50° field of view; color fundus image; centered on the macula:
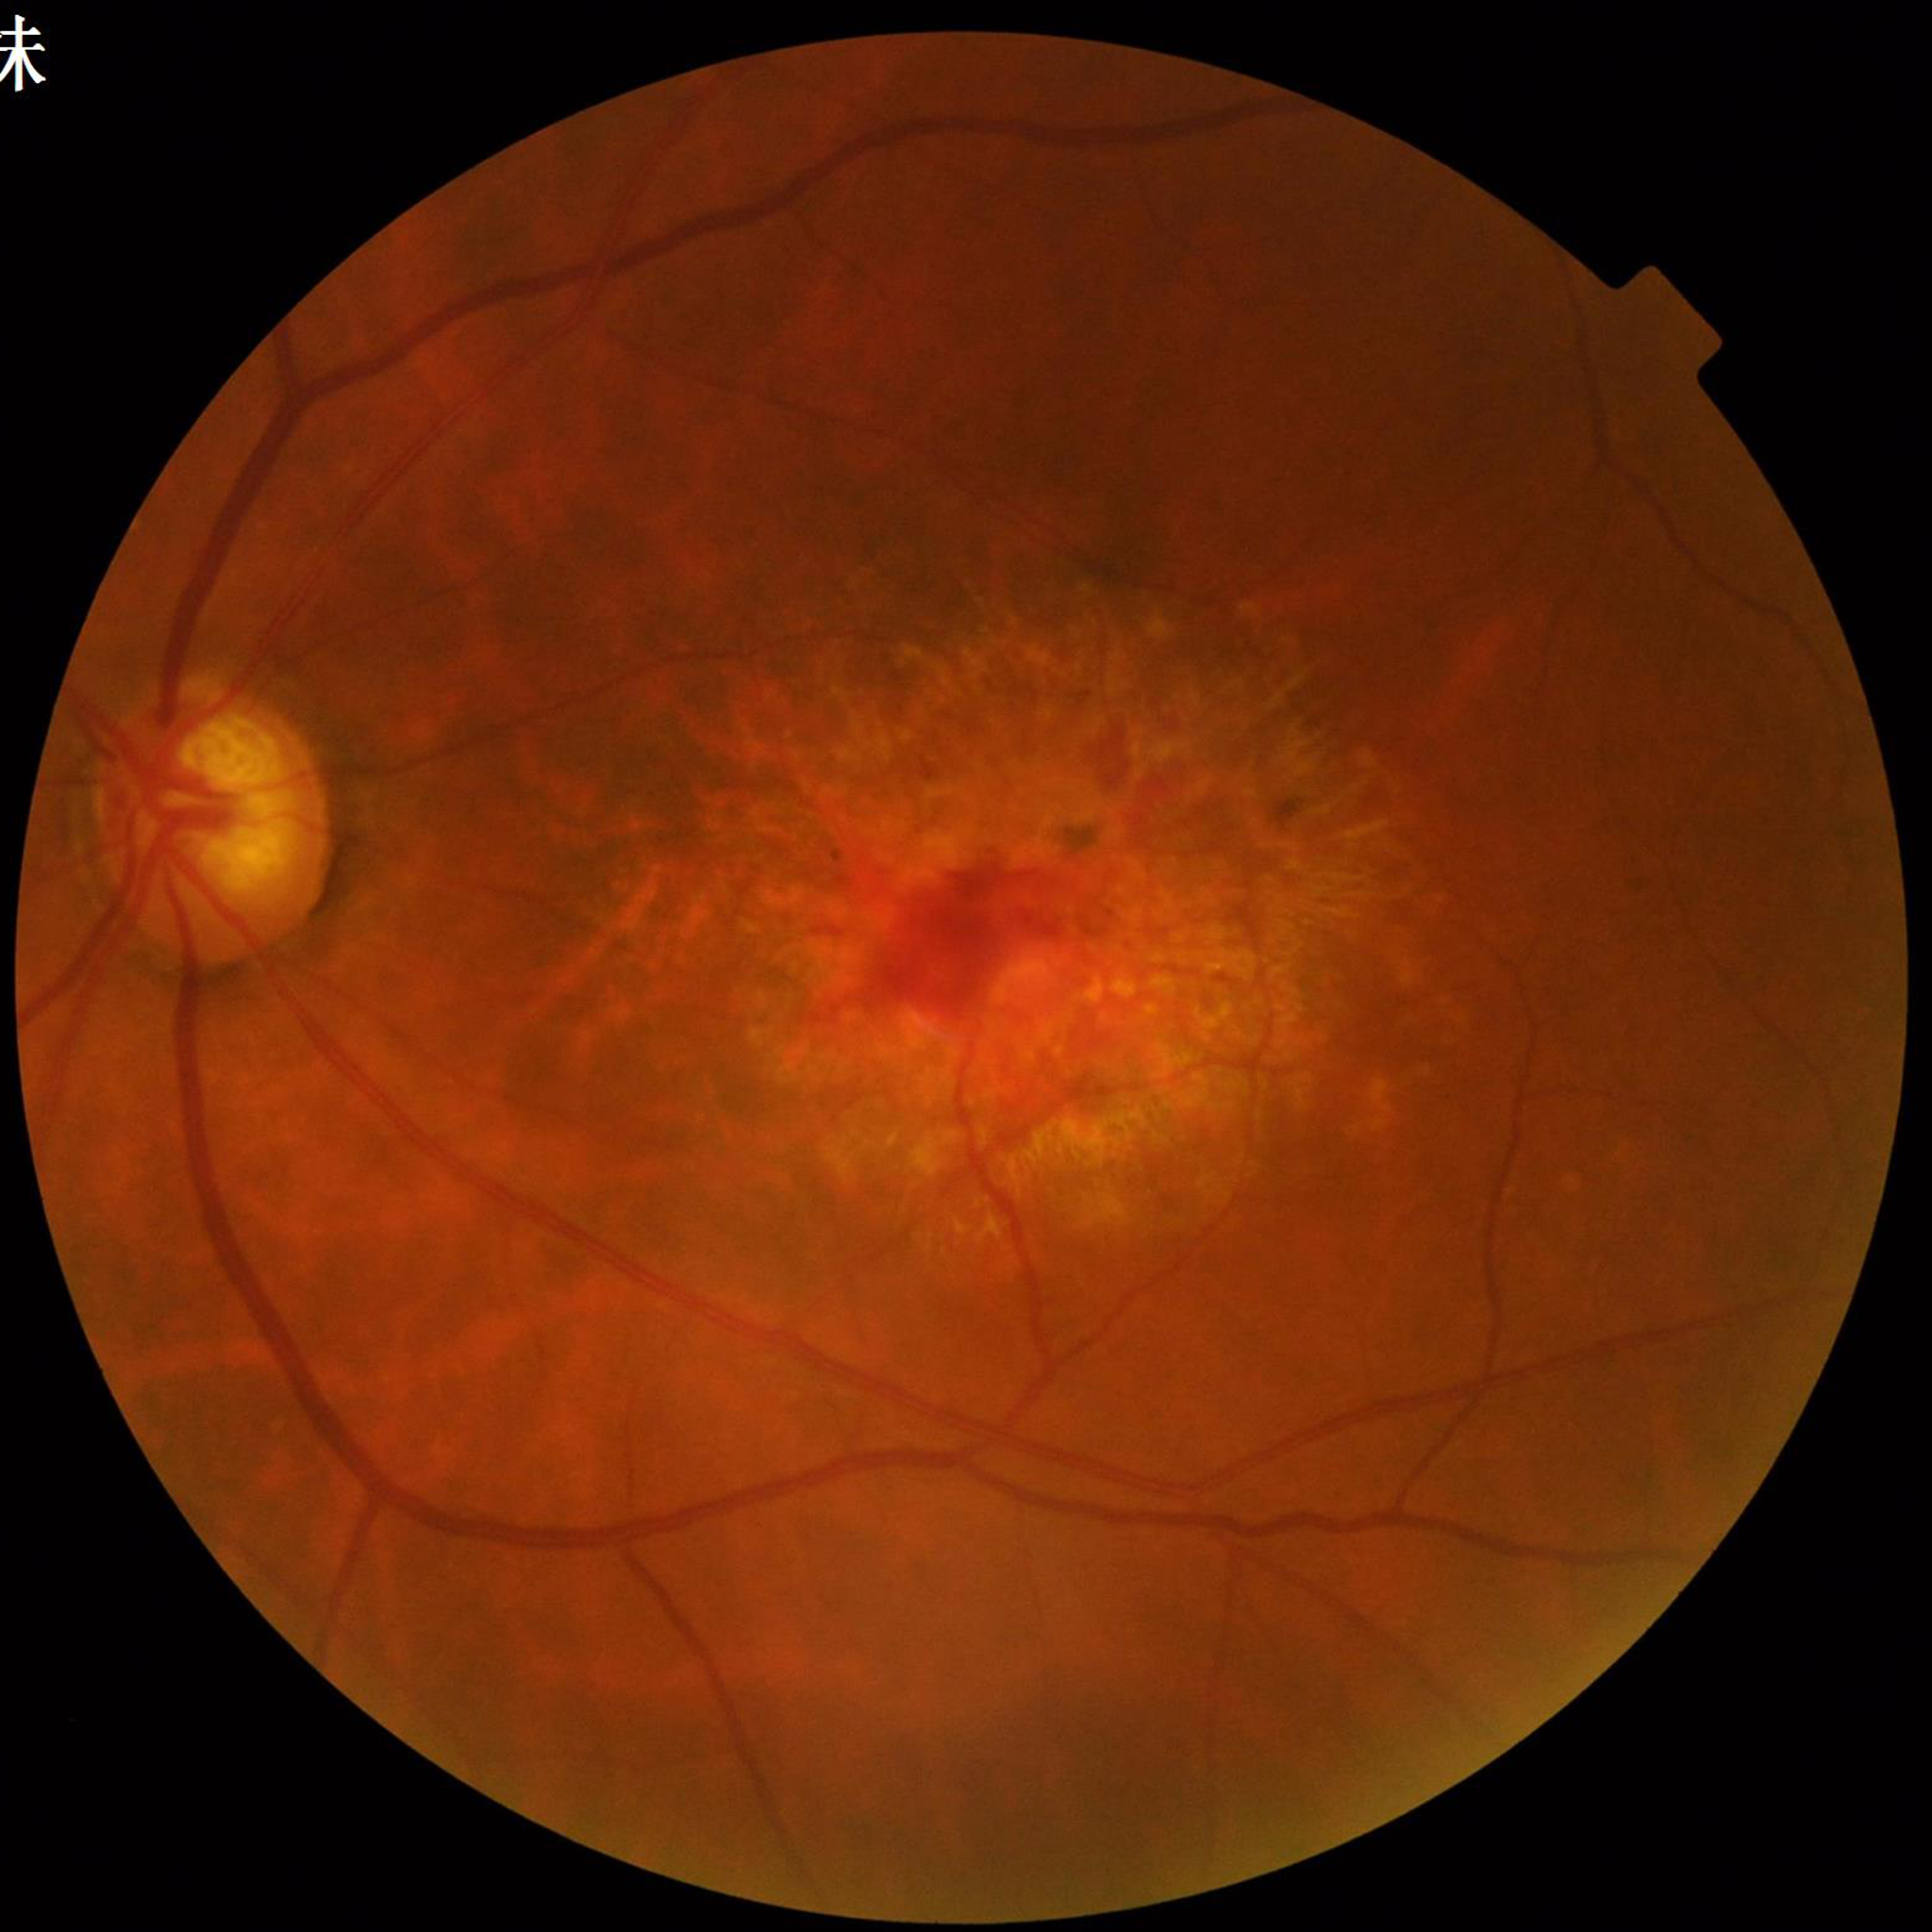
Quality: satisfactory.
The patient was diagnosed with age-related macular degeneration (AMD).